Posterior pole photograph. 45-degree field of view. NIDEK AFC-230 fundus camera. 848 by 848 pixels
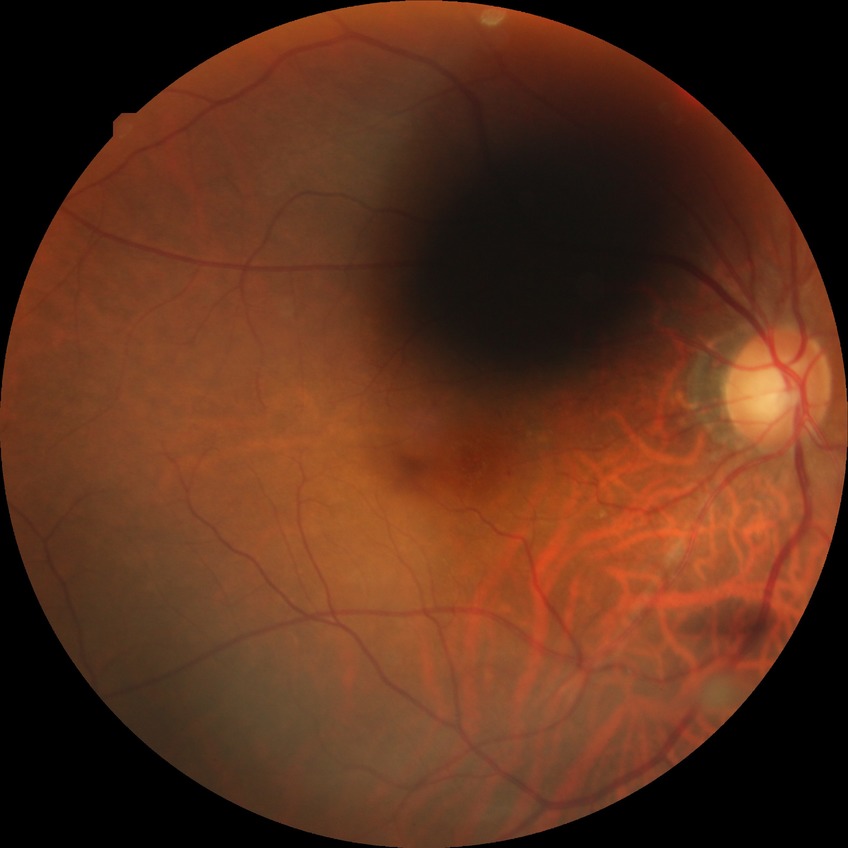
diabetic retinopathy (DR): NDR (no diabetic retinopathy).